No pharmacologic dilation
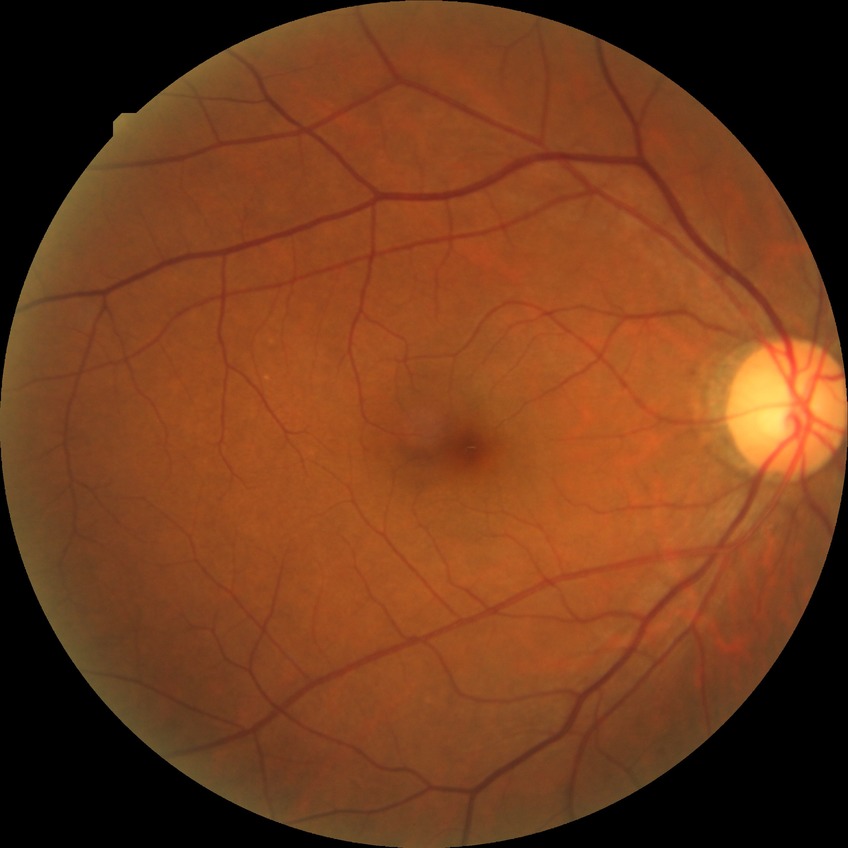
  davis_grade: no diabetic retinopathy